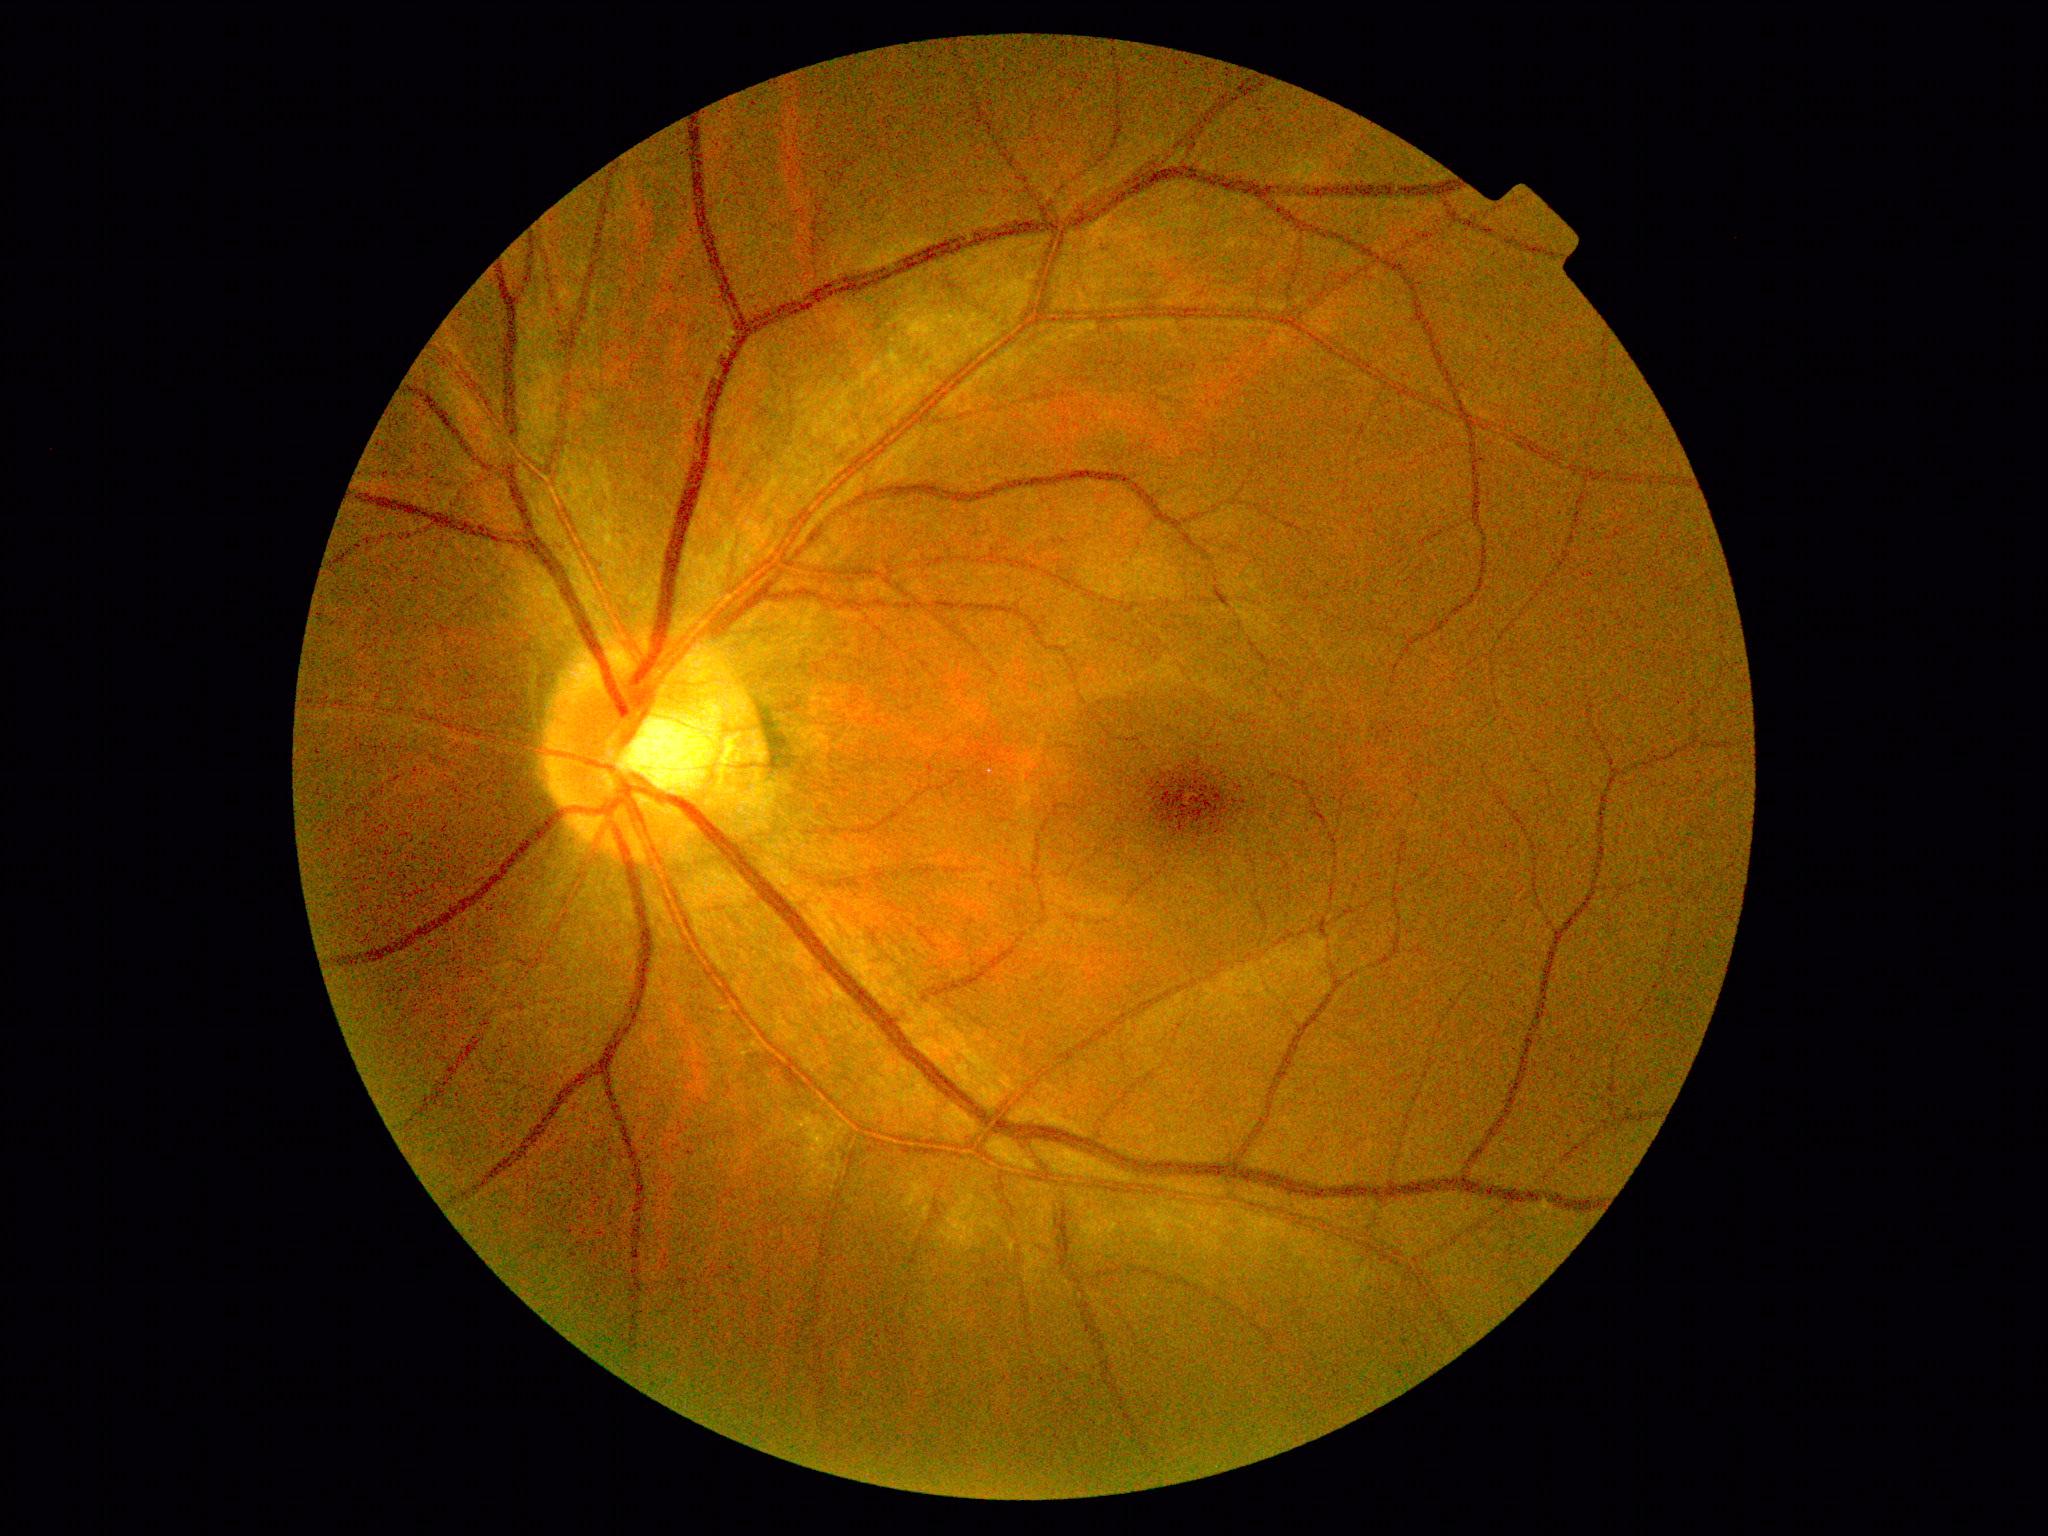
Diabetic retinopathy (DR): grade 0 (no apparent retinopathy).